FOV: 45 degrees; 2352x1568; CFP: 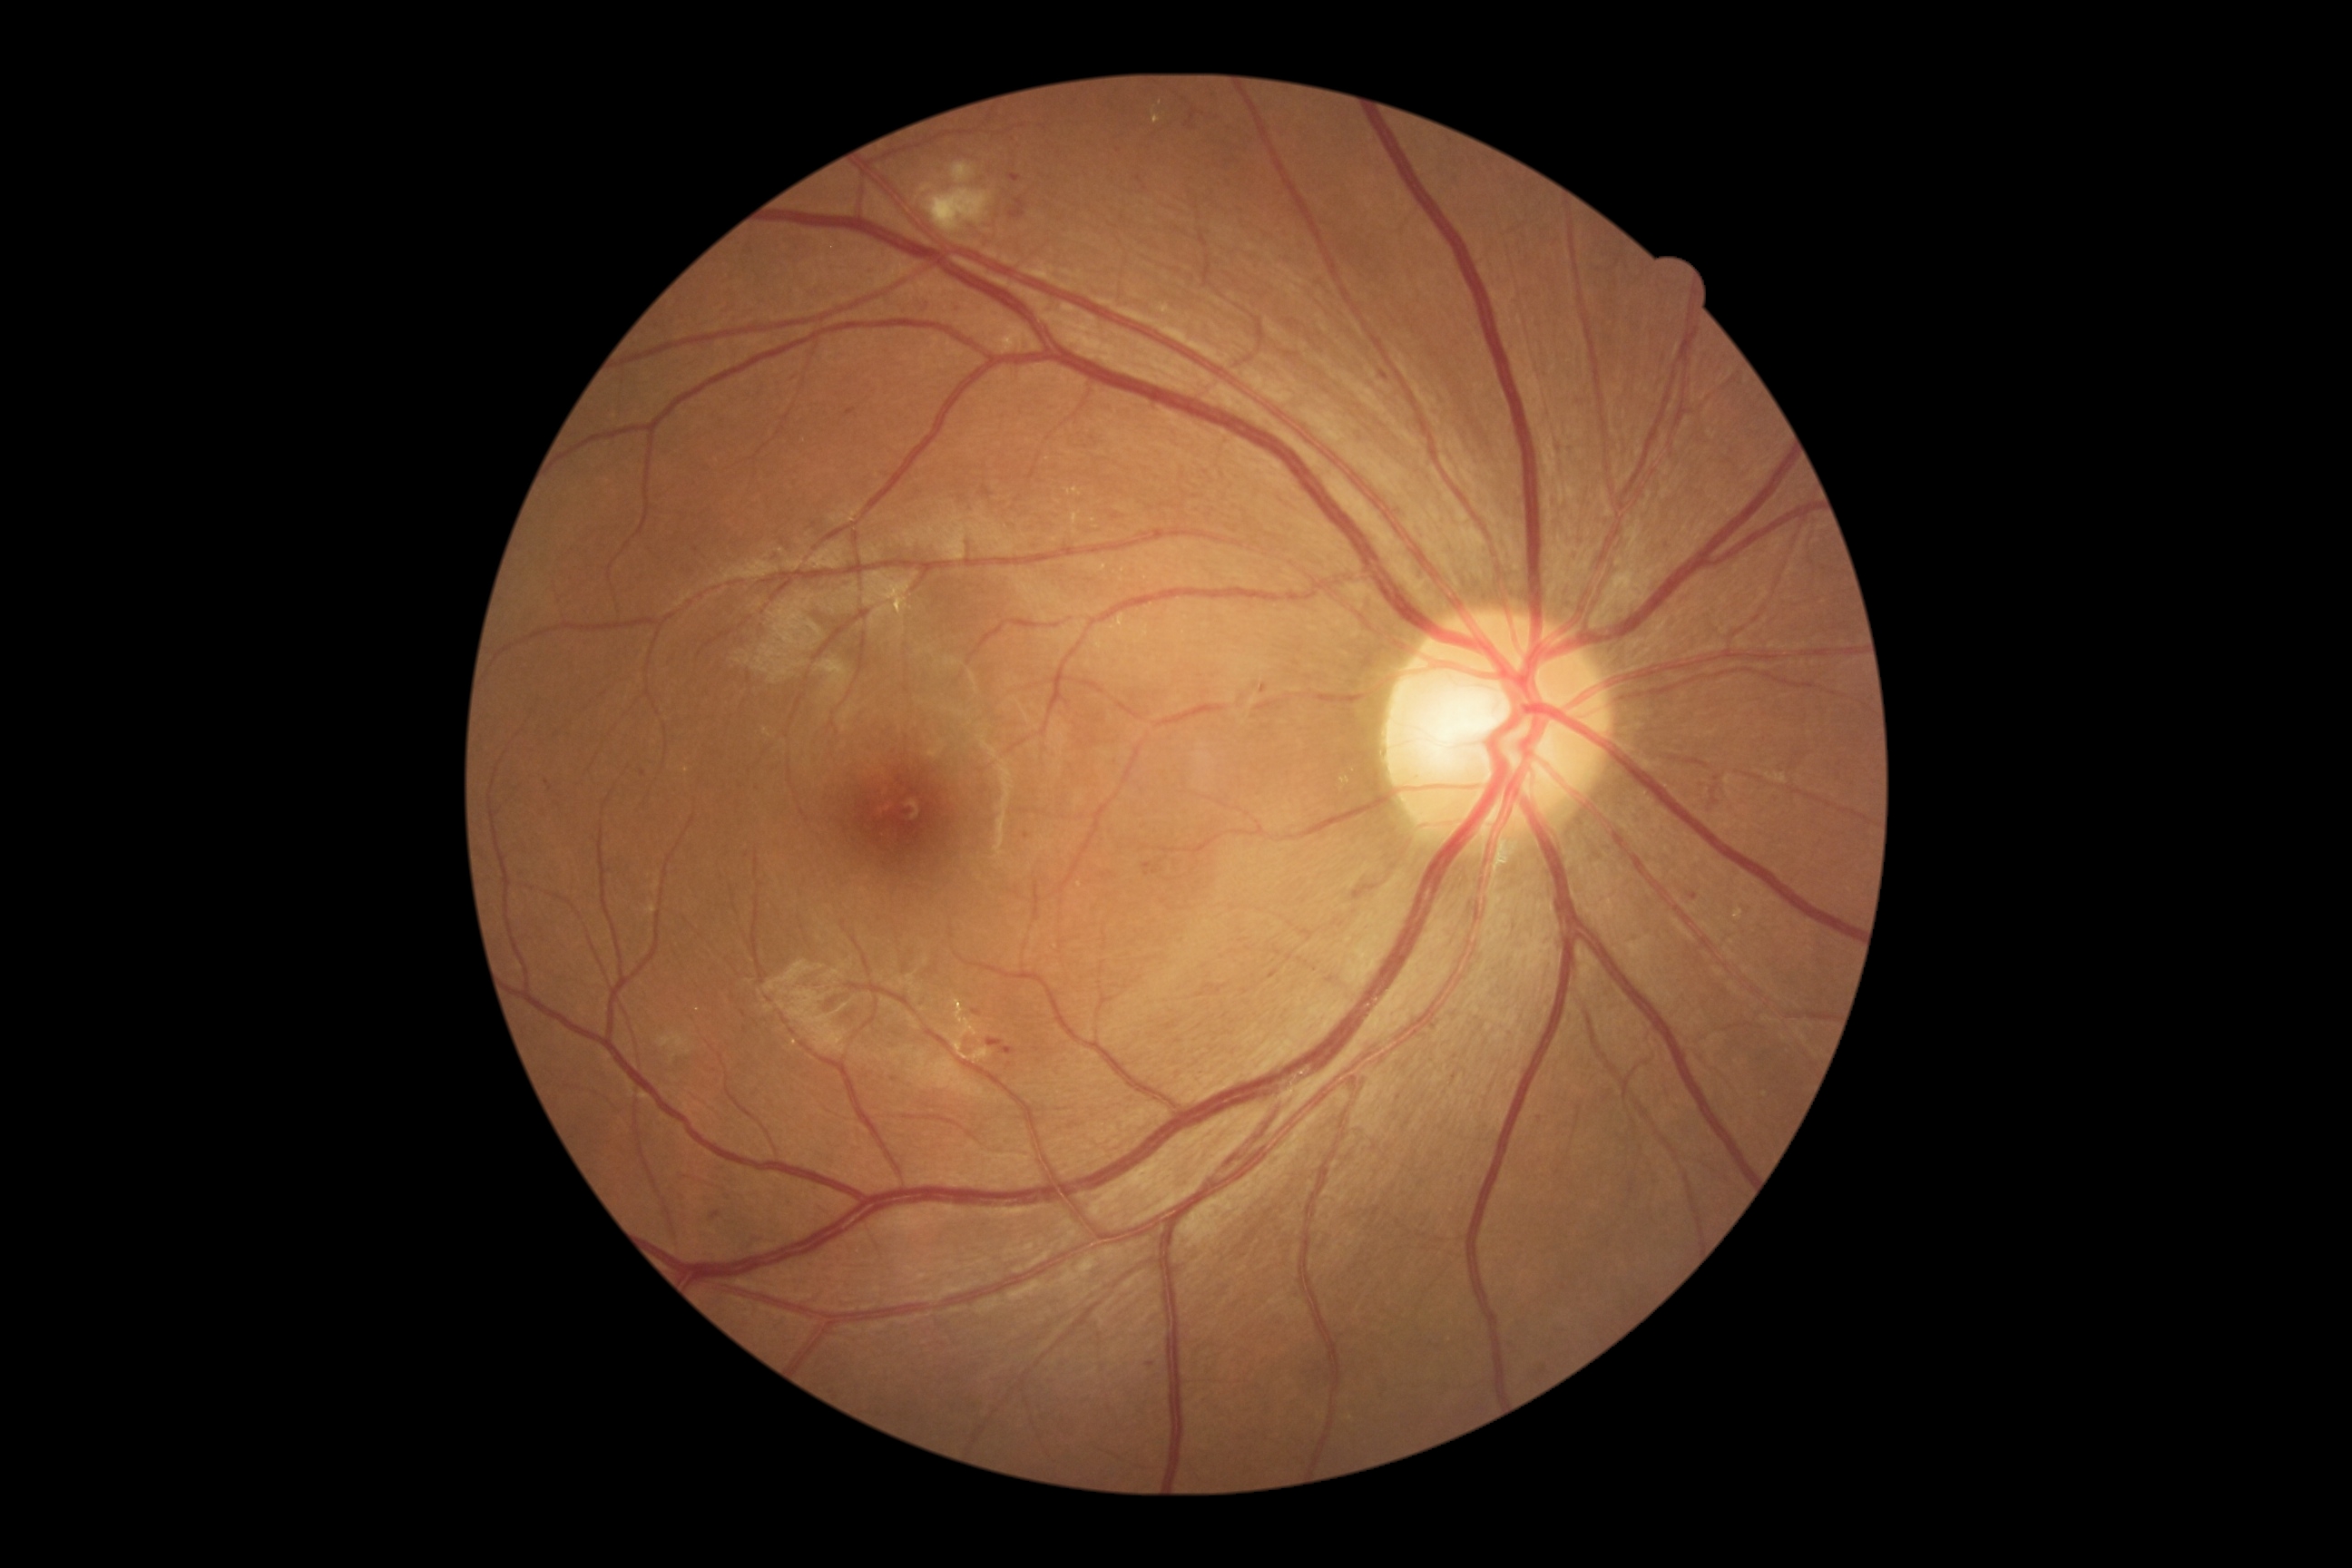 Diabetic retinopathy (DR) is grade 2 (moderate NPDR)
Representative lesions:
microaneurysms (MAs) (continued): BBox(1689, 892, 1698, 901) | BBox(867, 270, 876, 275) | BBox(787, 369, 799, 382) | BBox(545, 779, 553, 792) | BBox(847, 409, 856, 416) | BBox(1008, 173, 1021, 184) | BBox(1663, 544, 1672, 556) | BBox(1712, 785, 1720, 794) | BBox(1008, 197, 1026, 220)
Small MAs approximately at point(1119, 151) | point(1541, 1120) | point(1027, 836) | point(1729, 462)
hard exudates (EXs) (continued): BBox(1152, 108, 1161, 124) | BBox(1084, 558, 1108, 574) | BBox(1159, 306, 1171, 315) | BBox(906, 1268, 917, 1273) | BBox(1117, 614, 1124, 627) | BBox(1734, 908, 1745, 921) | BBox(1340, 774, 1357, 792)
Small EXs approximately at point(1113, 629) | point(1765, 1095) | point(1081, 885) | point(1059, 503) | point(795, 1043)